Phoenix ICON wide-field infant fundus image. 1240 x 1240 pixels. Acquired on the Phoenix ICON — 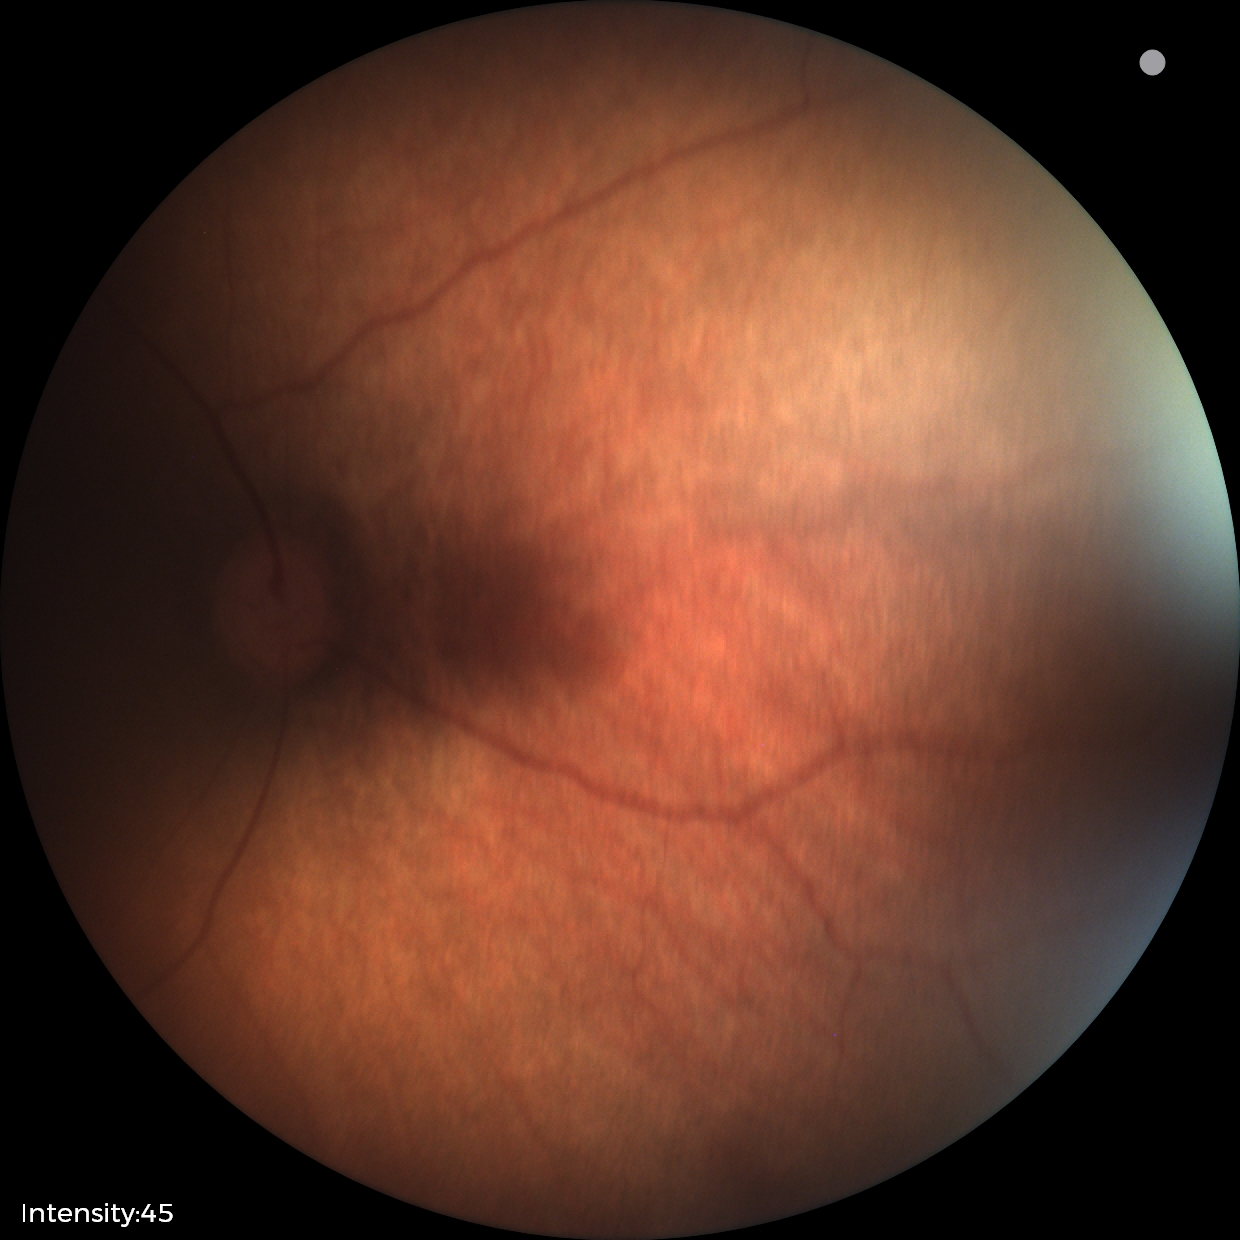
Physiological retinal appearance for postconceptual age.